FOV: 45 degrees. 2352 x 1568 pixels.
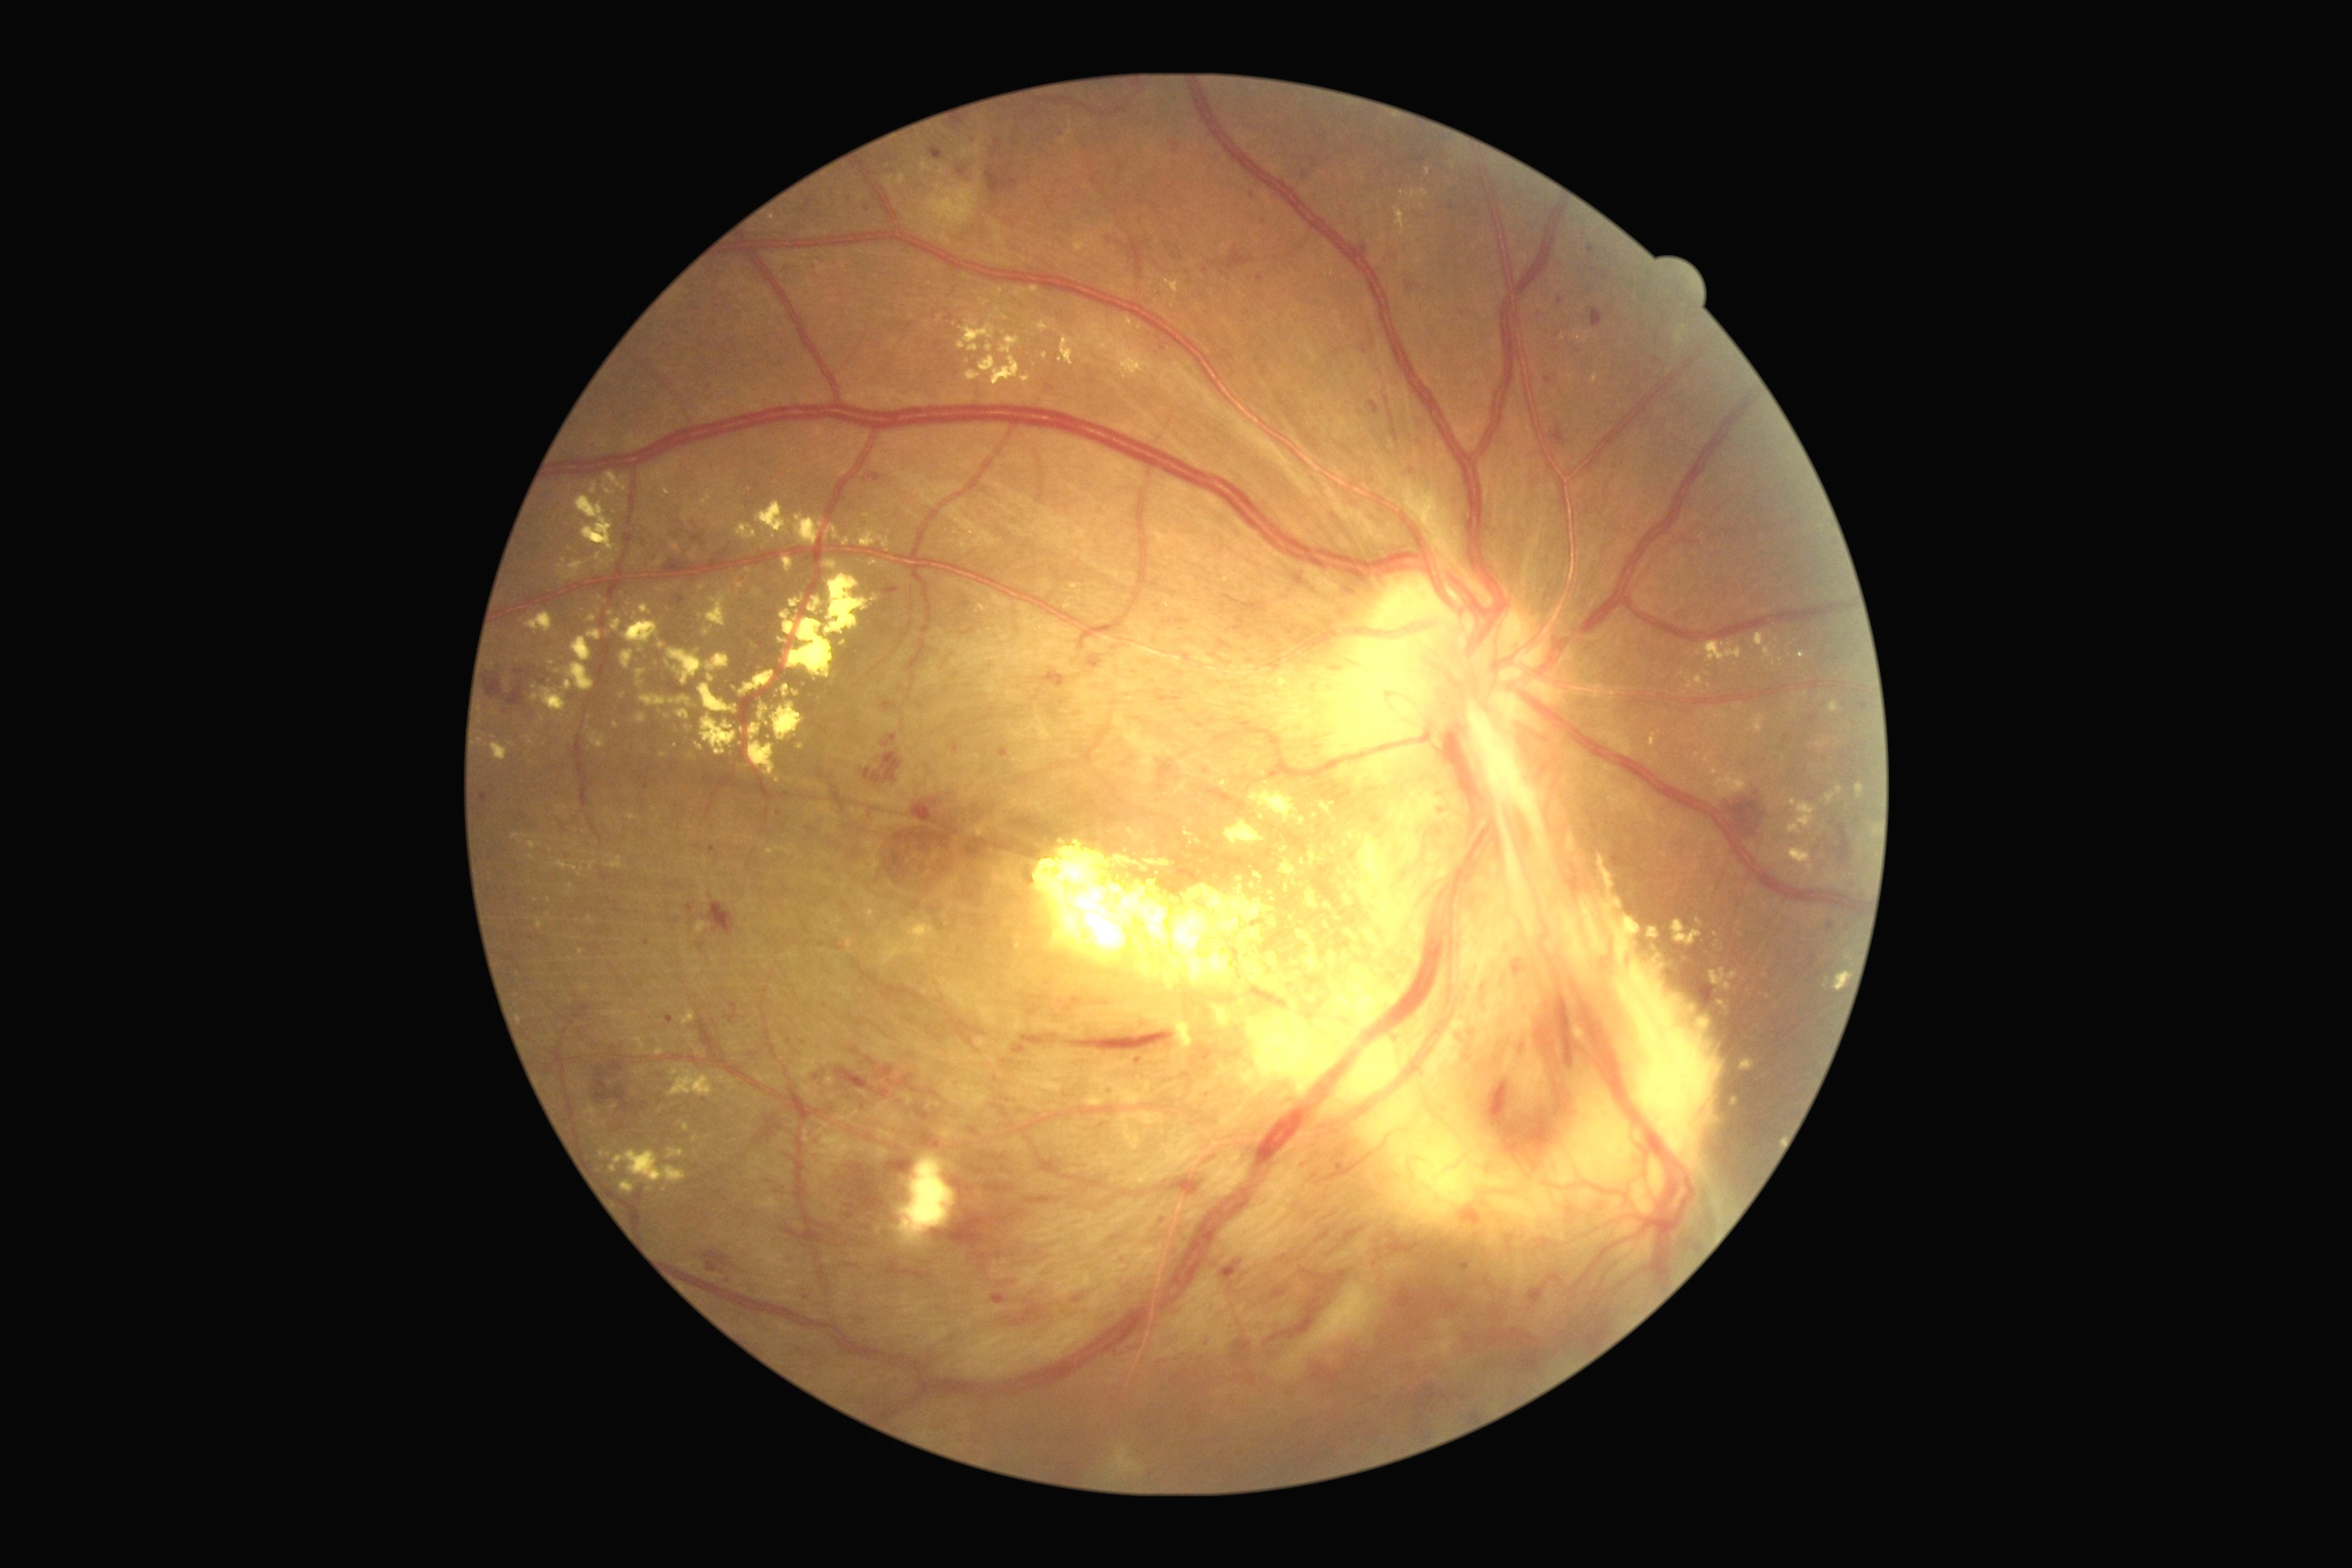
{"partial": true, "dr_grade": 4, "lesions": {"ex": [[808, 598, 821, 614], [1756, 632, 1774, 662], [781, 574, 877, 683], [783, 558, 794, 573], [1164, 280, 1184, 295], [700, 591, 732, 636], [1698, 642, 1743, 663], [867, 910, 876, 919], [986, 344, 994, 353], [767, 847, 778, 856], [1037, 322, 1050, 333], [1320, 801, 1337, 823], [589, 917, 594, 925]], "ex_small_approx": [[1806, 696], [1053, 323], [599, 1168], [1346, 845], [1006, 319], [1327, 906], [743, 730]], "he": [[1233, 1340, 1251, 1358], [609, 1059, 625, 1072], [1271, 1289, 1288, 1298], [1827, 825, 1852, 867], [865, 475, 883, 484], [694, 527, 707, 545], [1553, 990, 1574, 1075], [1222, 1260, 1242, 1280], [994, 139, 1003, 153], [516, 669, 525, 676], [1170, 1177, 1200, 1197], [1088, 656, 1102, 669], [1222, 250, 1255, 273], [934, 1208, 1008, 1250], [883, 703, 897, 710], [487, 678, 527, 709], [952, 1177, 974, 1200], [1810, 957, 1818, 966]], "he_small_approx": [[482, 817], [804, 211]]}}